Color fundus photograph
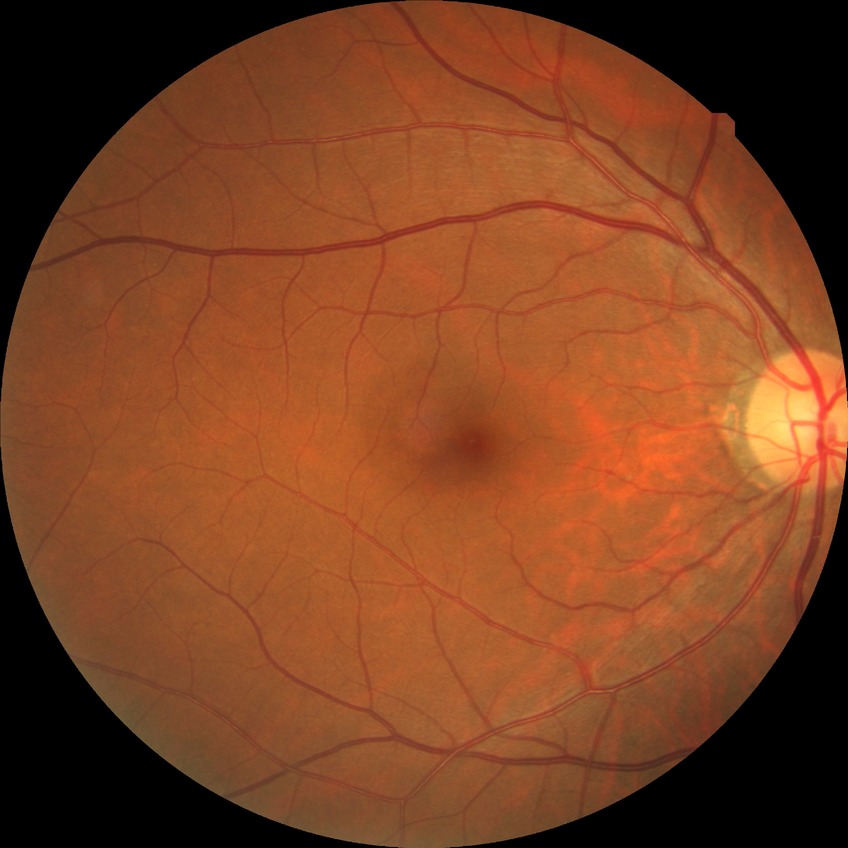

diabetic retinopathy (DR)@no diabetic retinopathy (NDR).